848 x 848 pixels; 45° field of view: 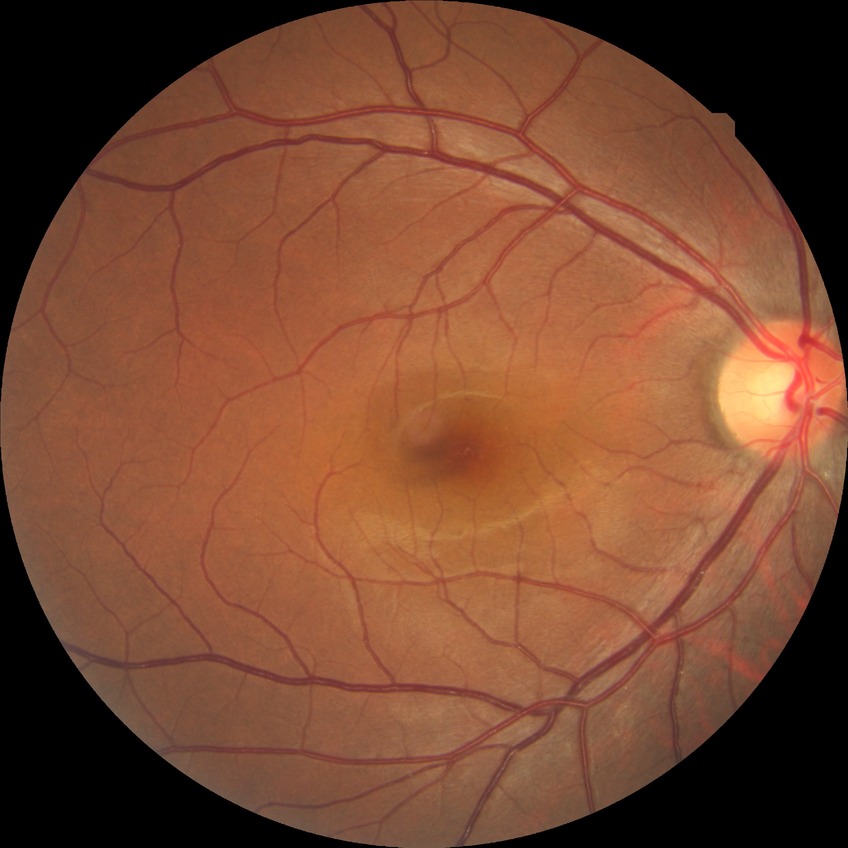

diabetic retinopathy (DR): NDR (no diabetic retinopathy).